848 x 848 pixels · posterior pole photograph · 45° FOV · NIDEK AFC-230 fundus camera.
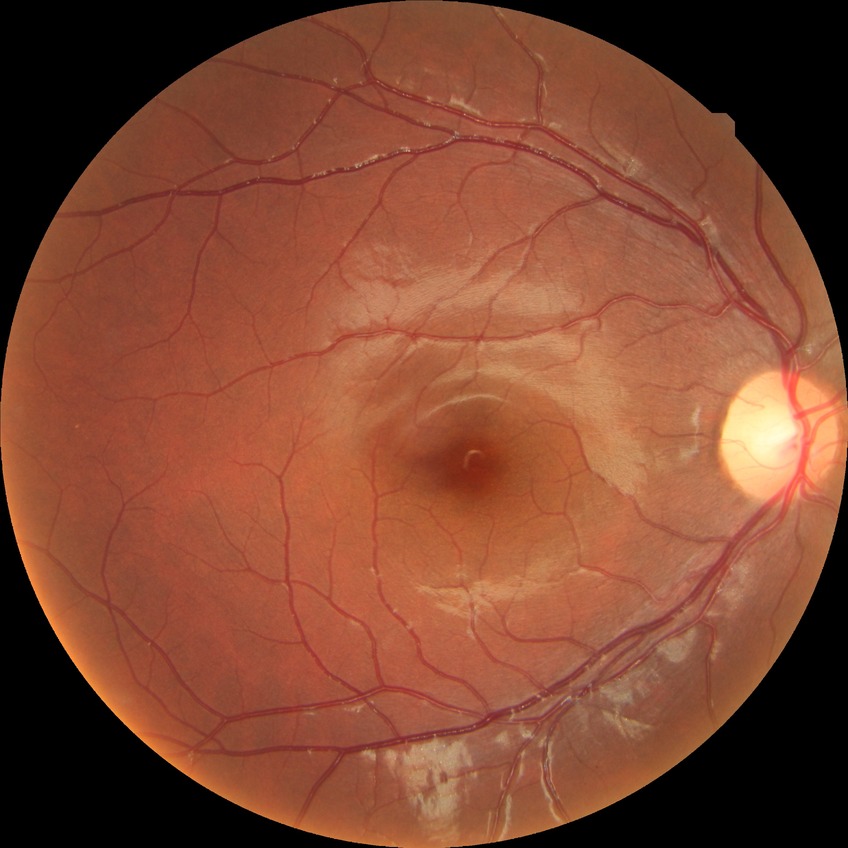 Davis grade = NDR.